130° field of view (Clarity RetCam 3) · wide-field contact fundus photograph of an infant:
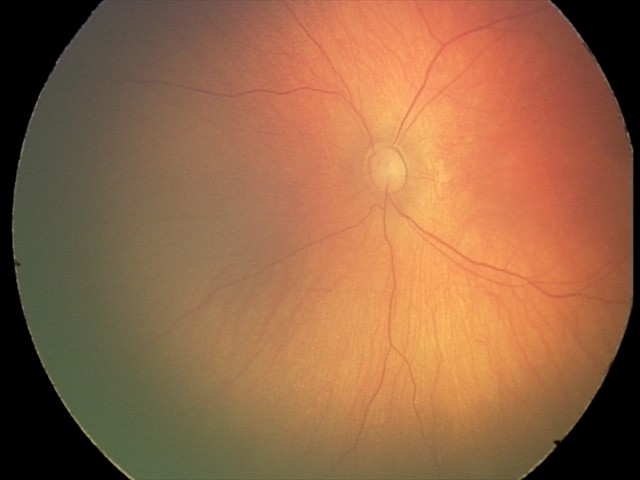
Physiological retinal appearance for postconceptual age.